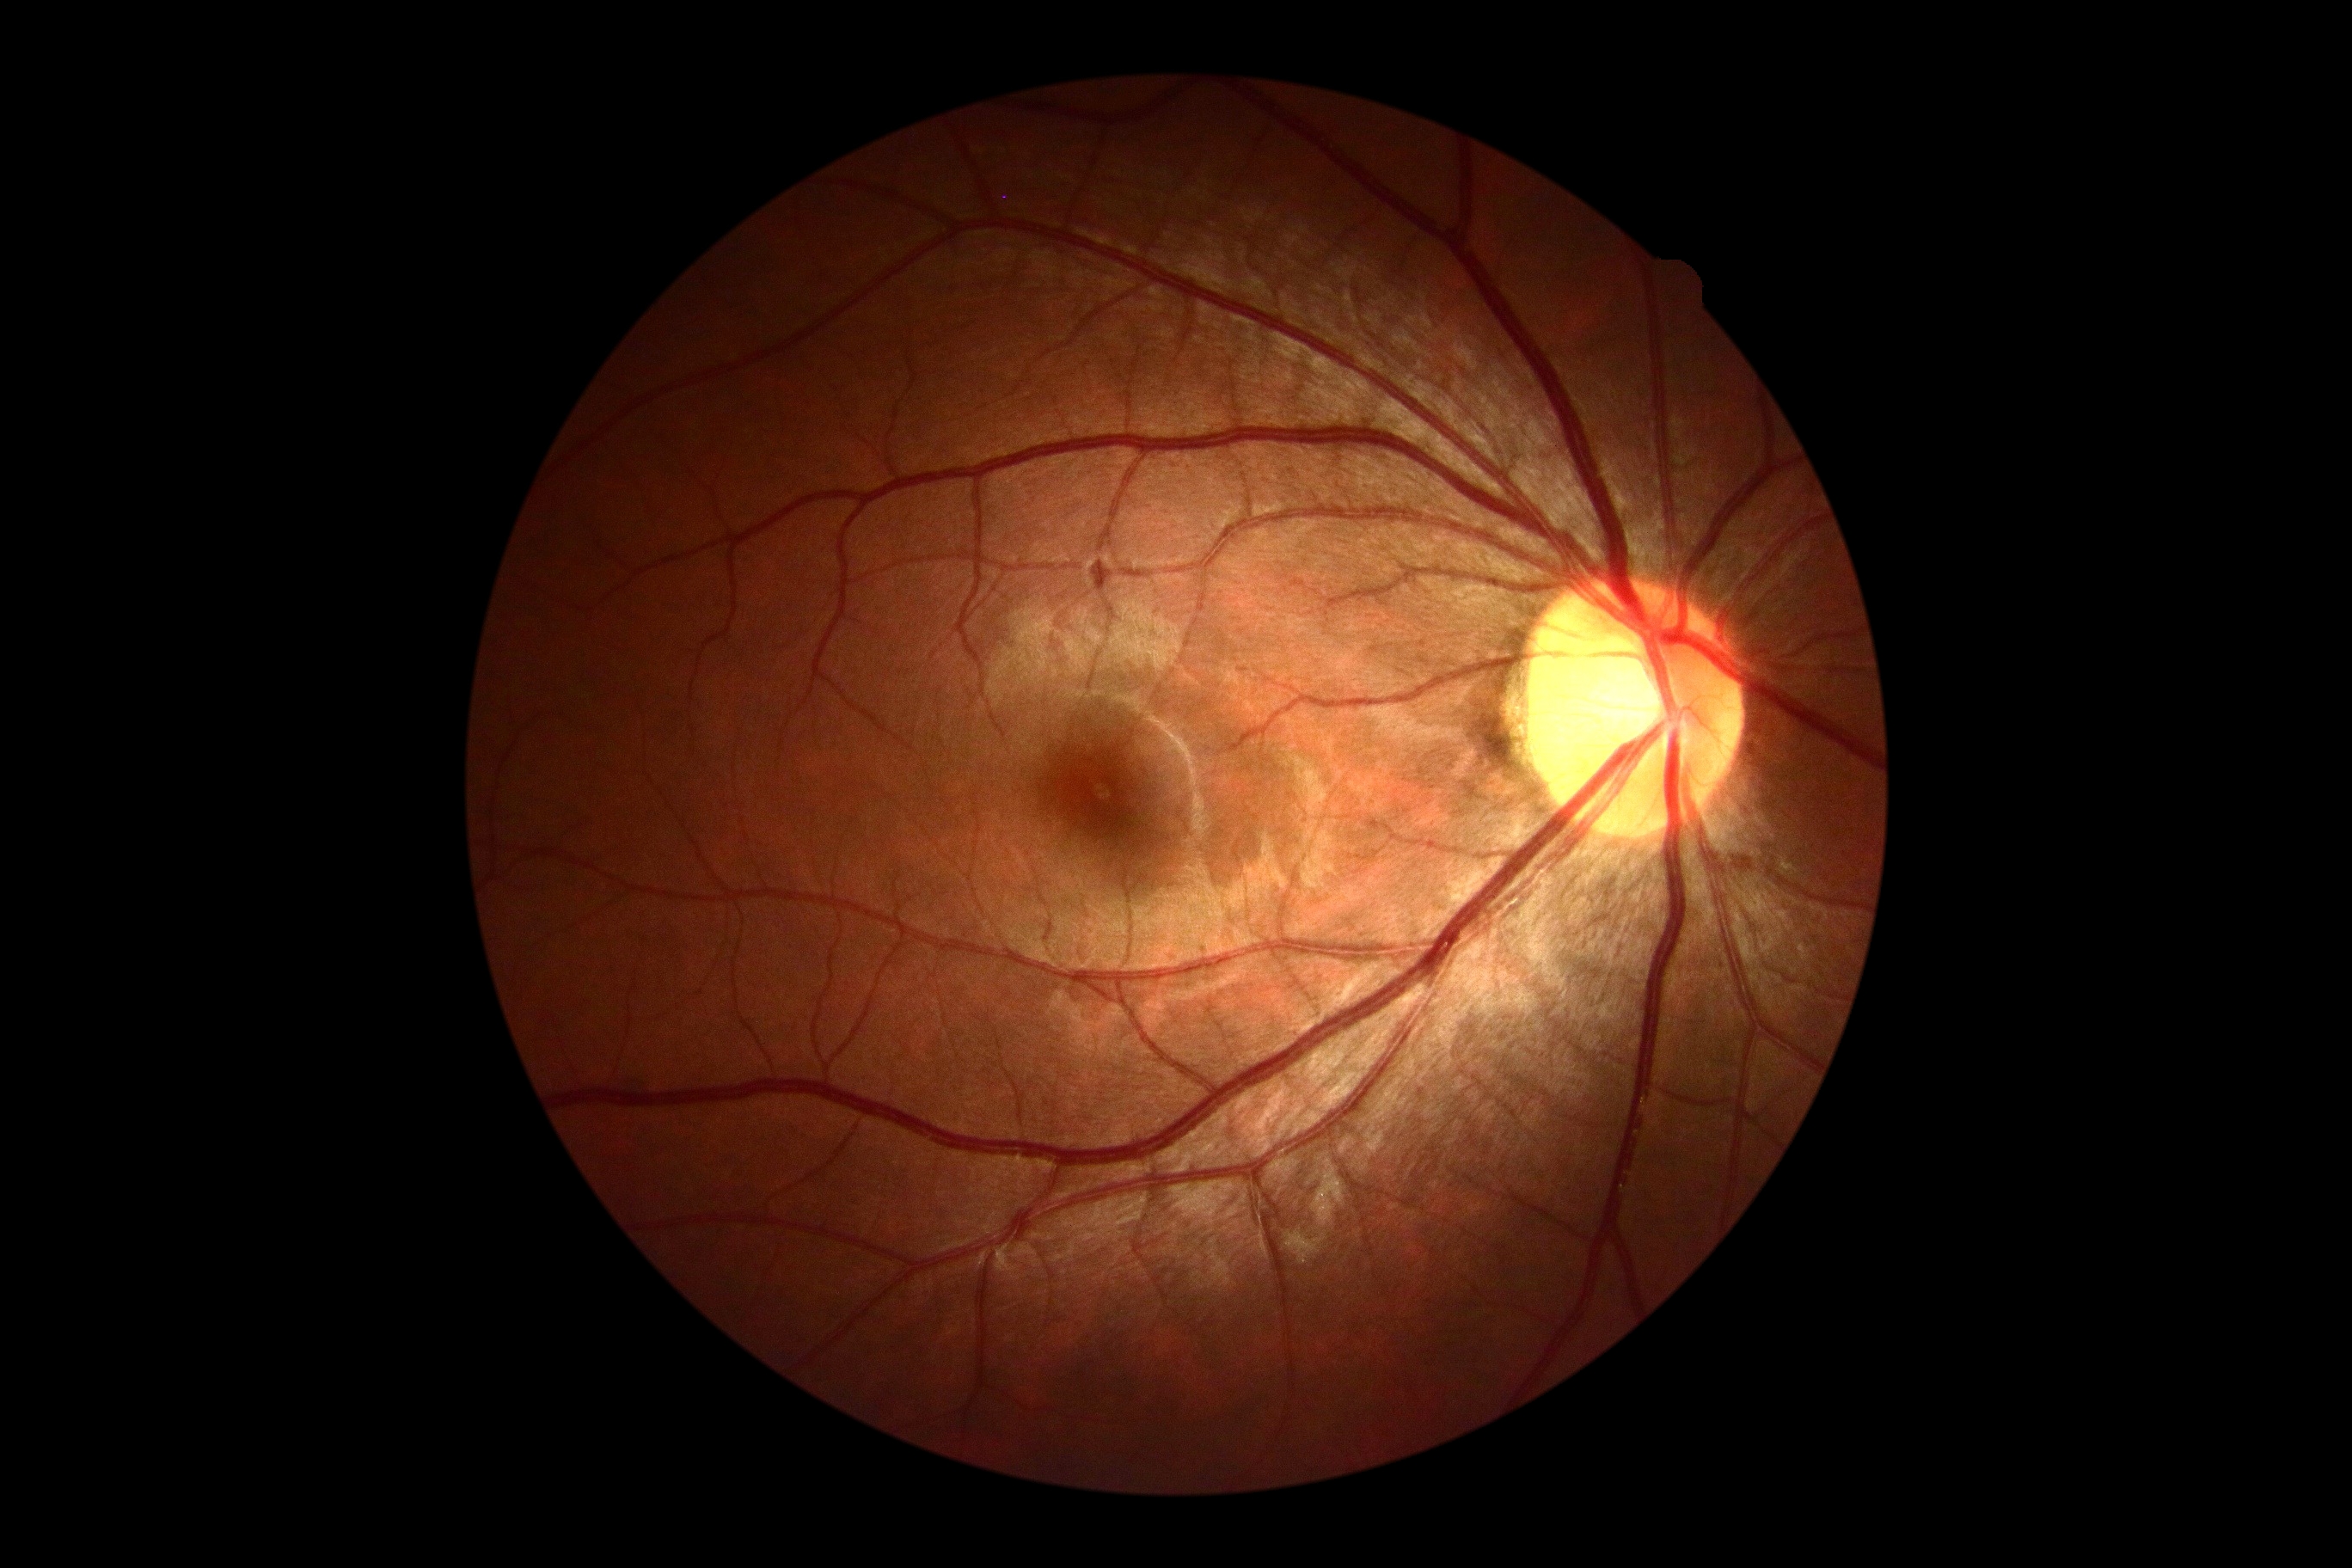 Diabetic retinopathy (DR): grade 0.